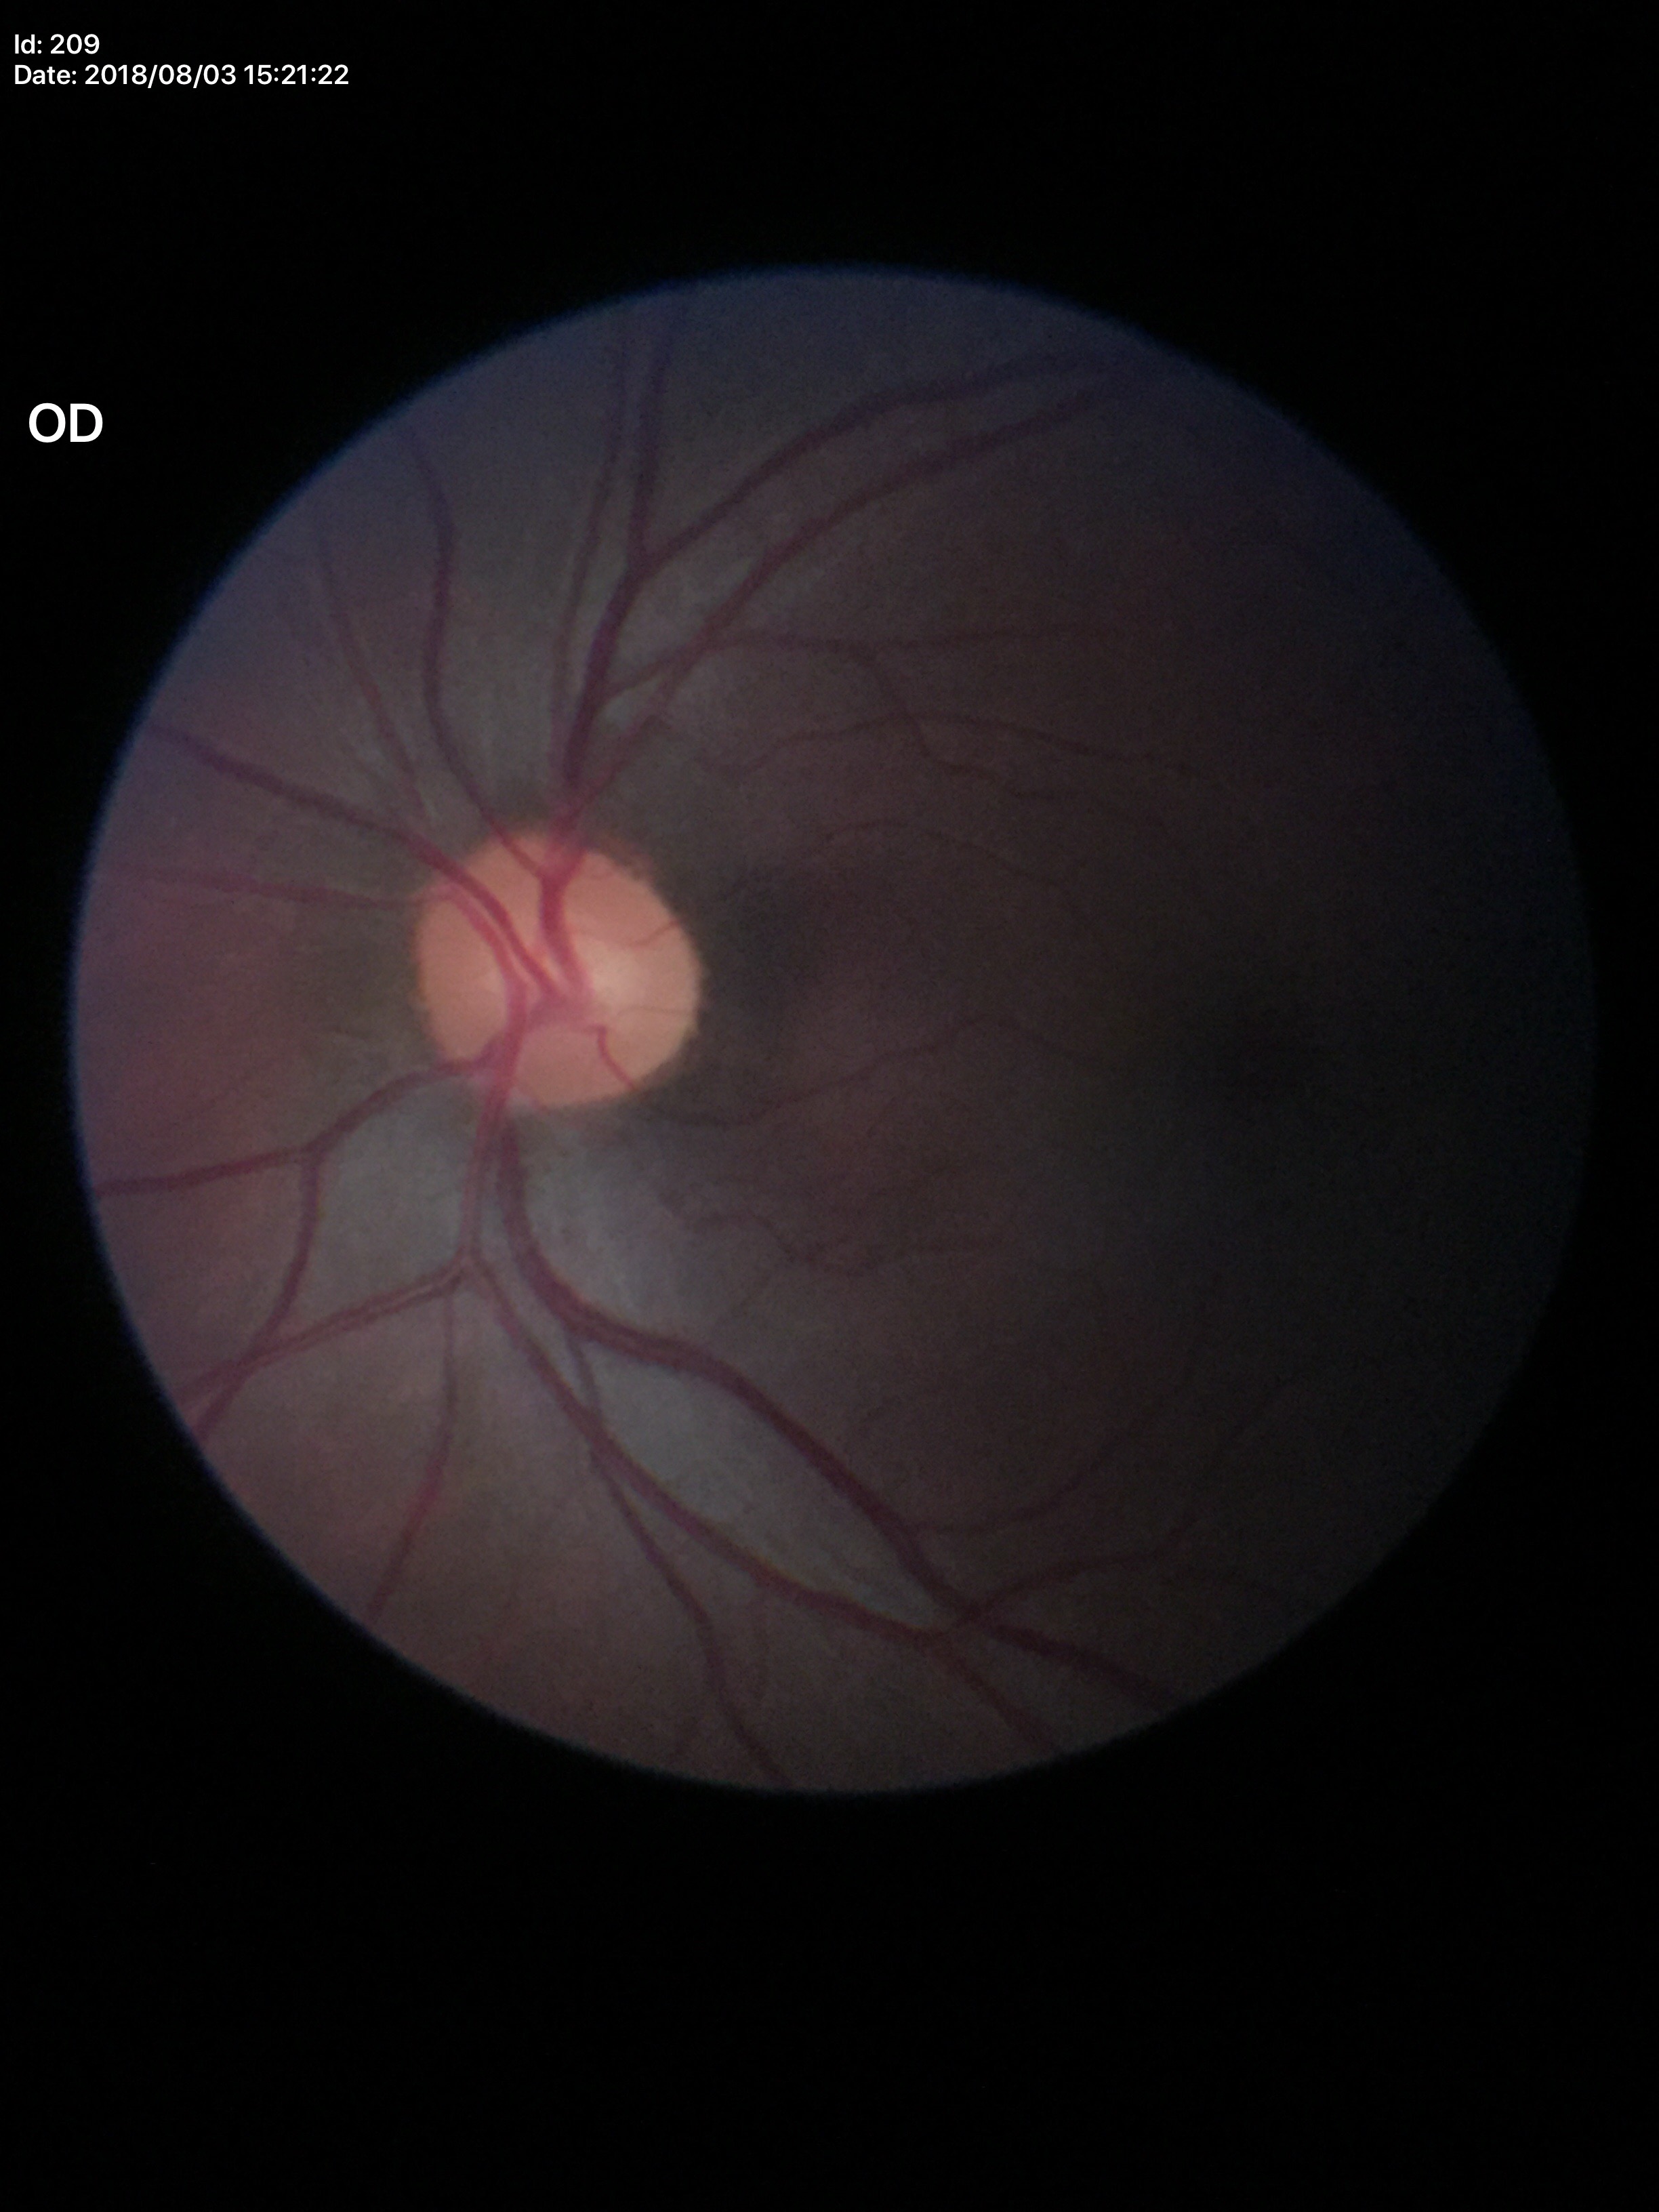
Glaucoma evaluation: not suspect.
Area CDR of 0.26.
Vertical cup-disc ratio is 0.48.
Horizontal cup-disc ratio is 0.54.